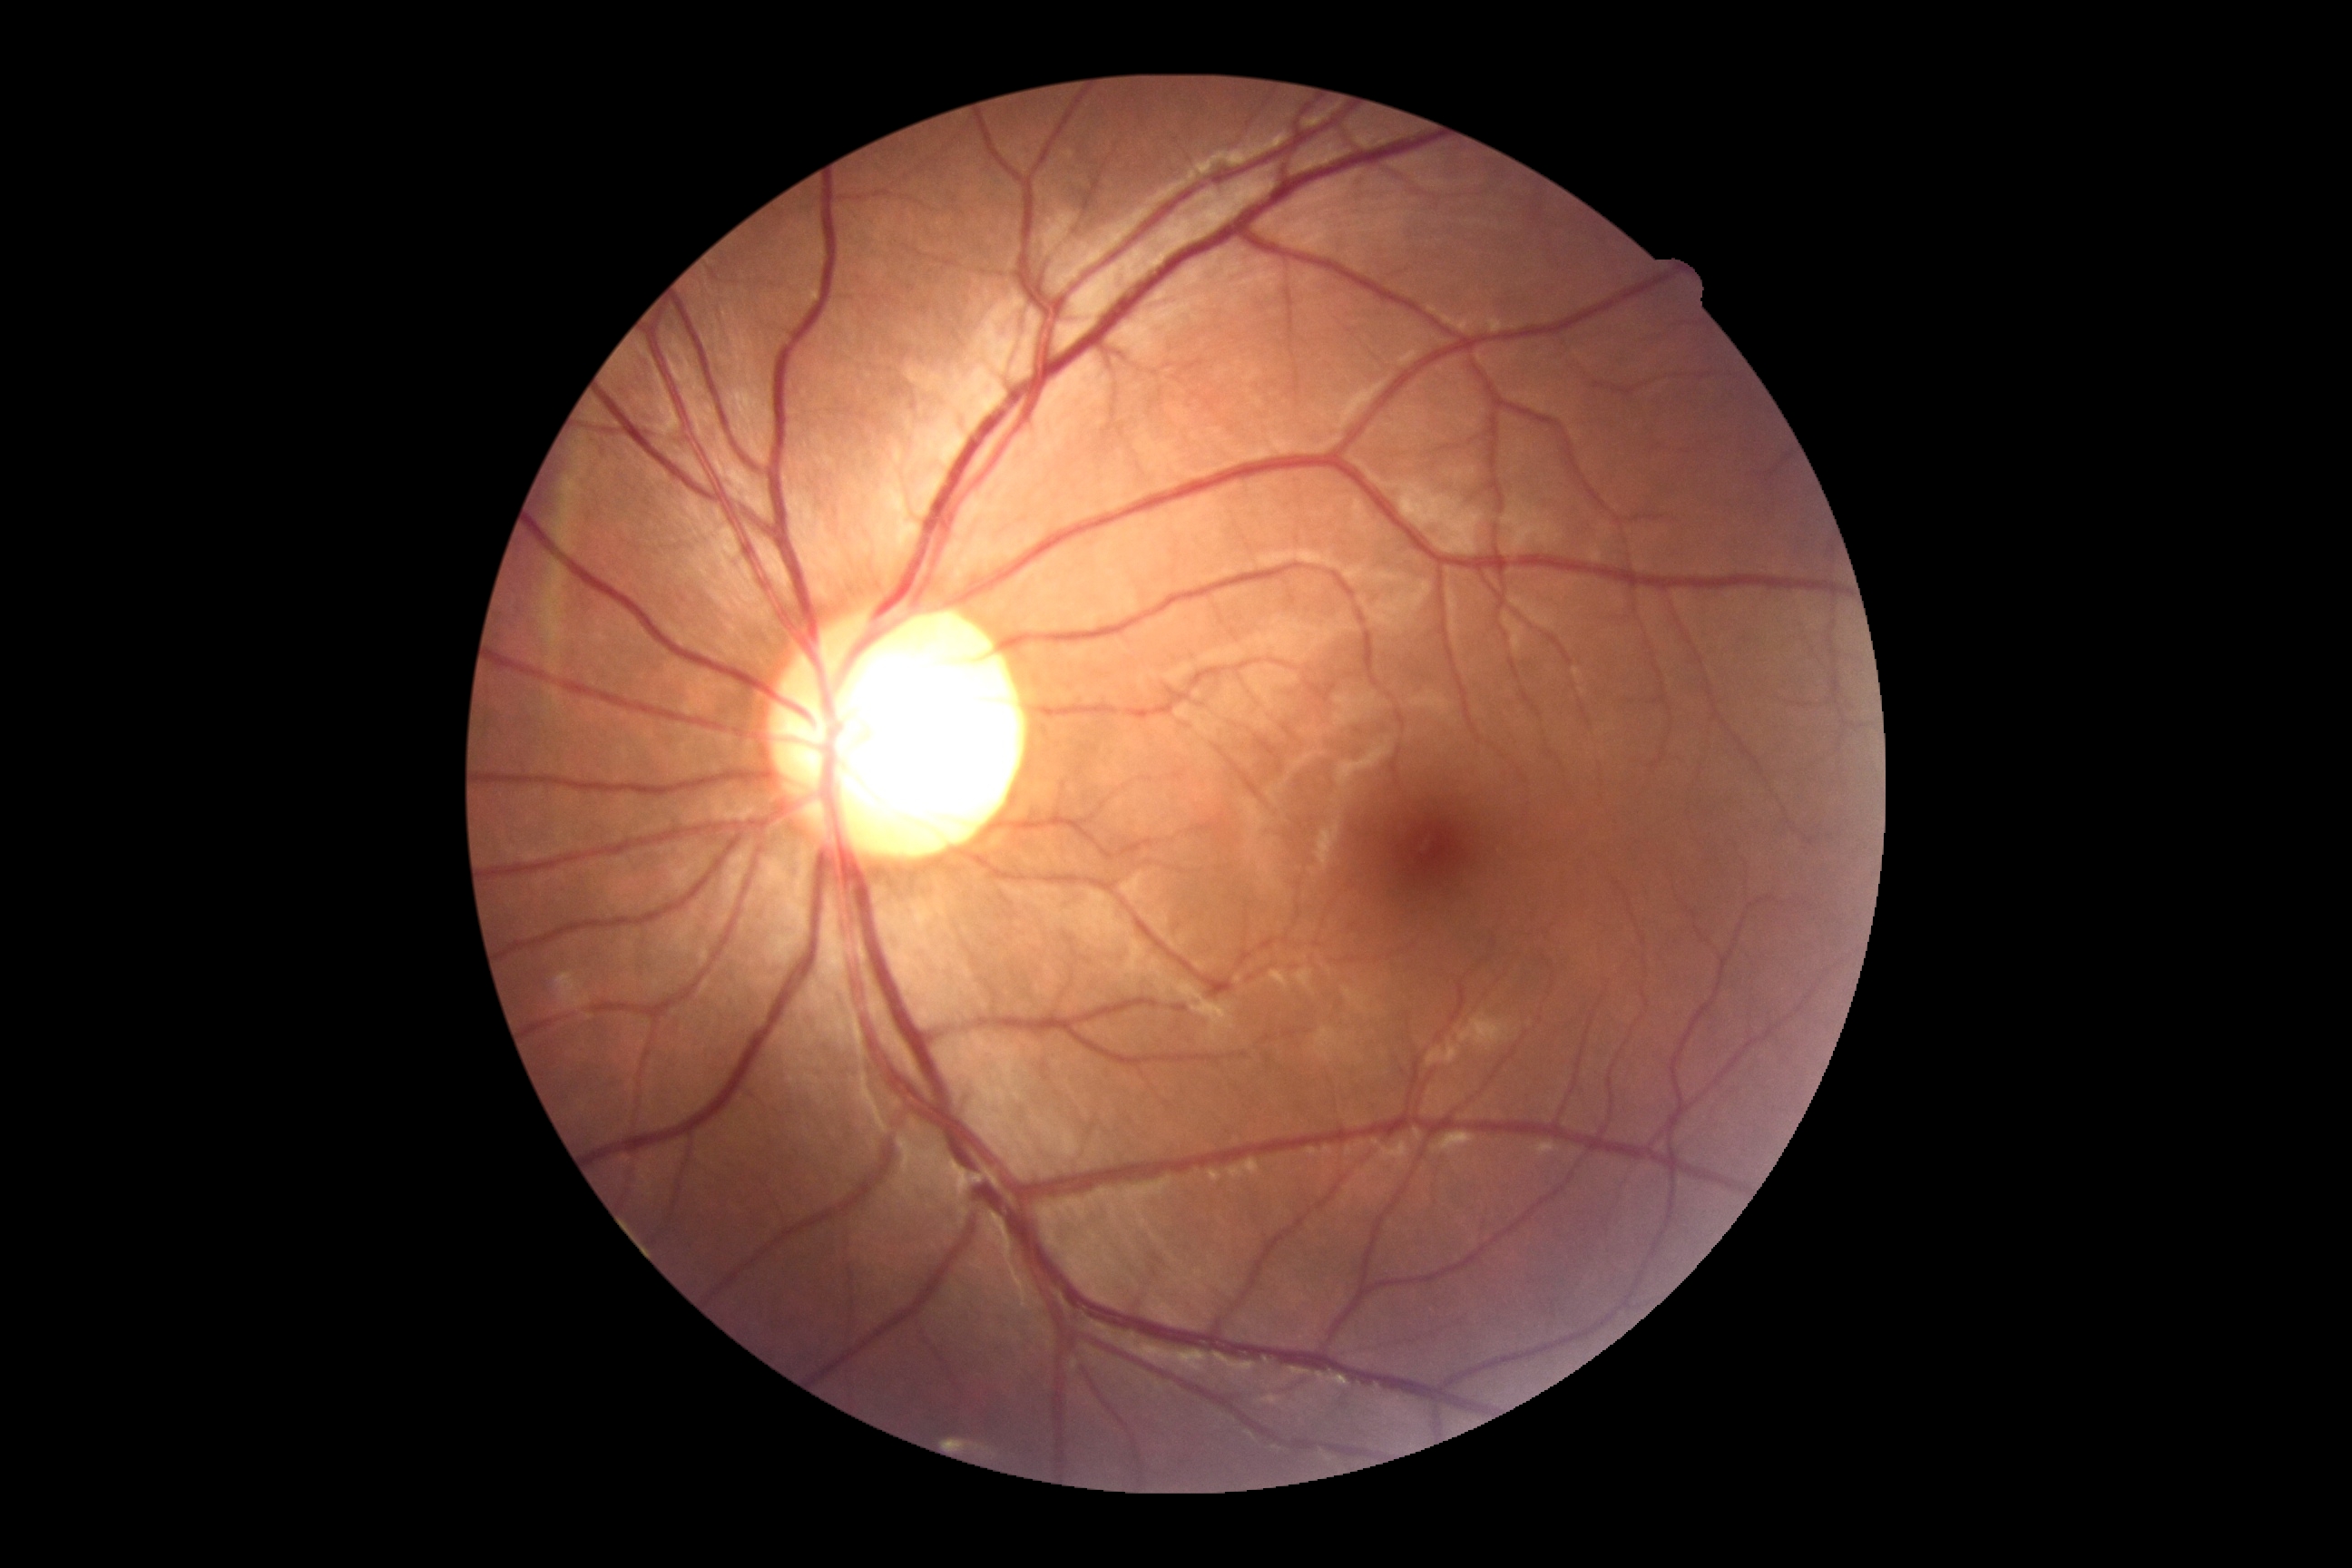
Retinopathy grade is 0.